2361 by 1568 pixels. Fundus photo. Macula at the center of the field
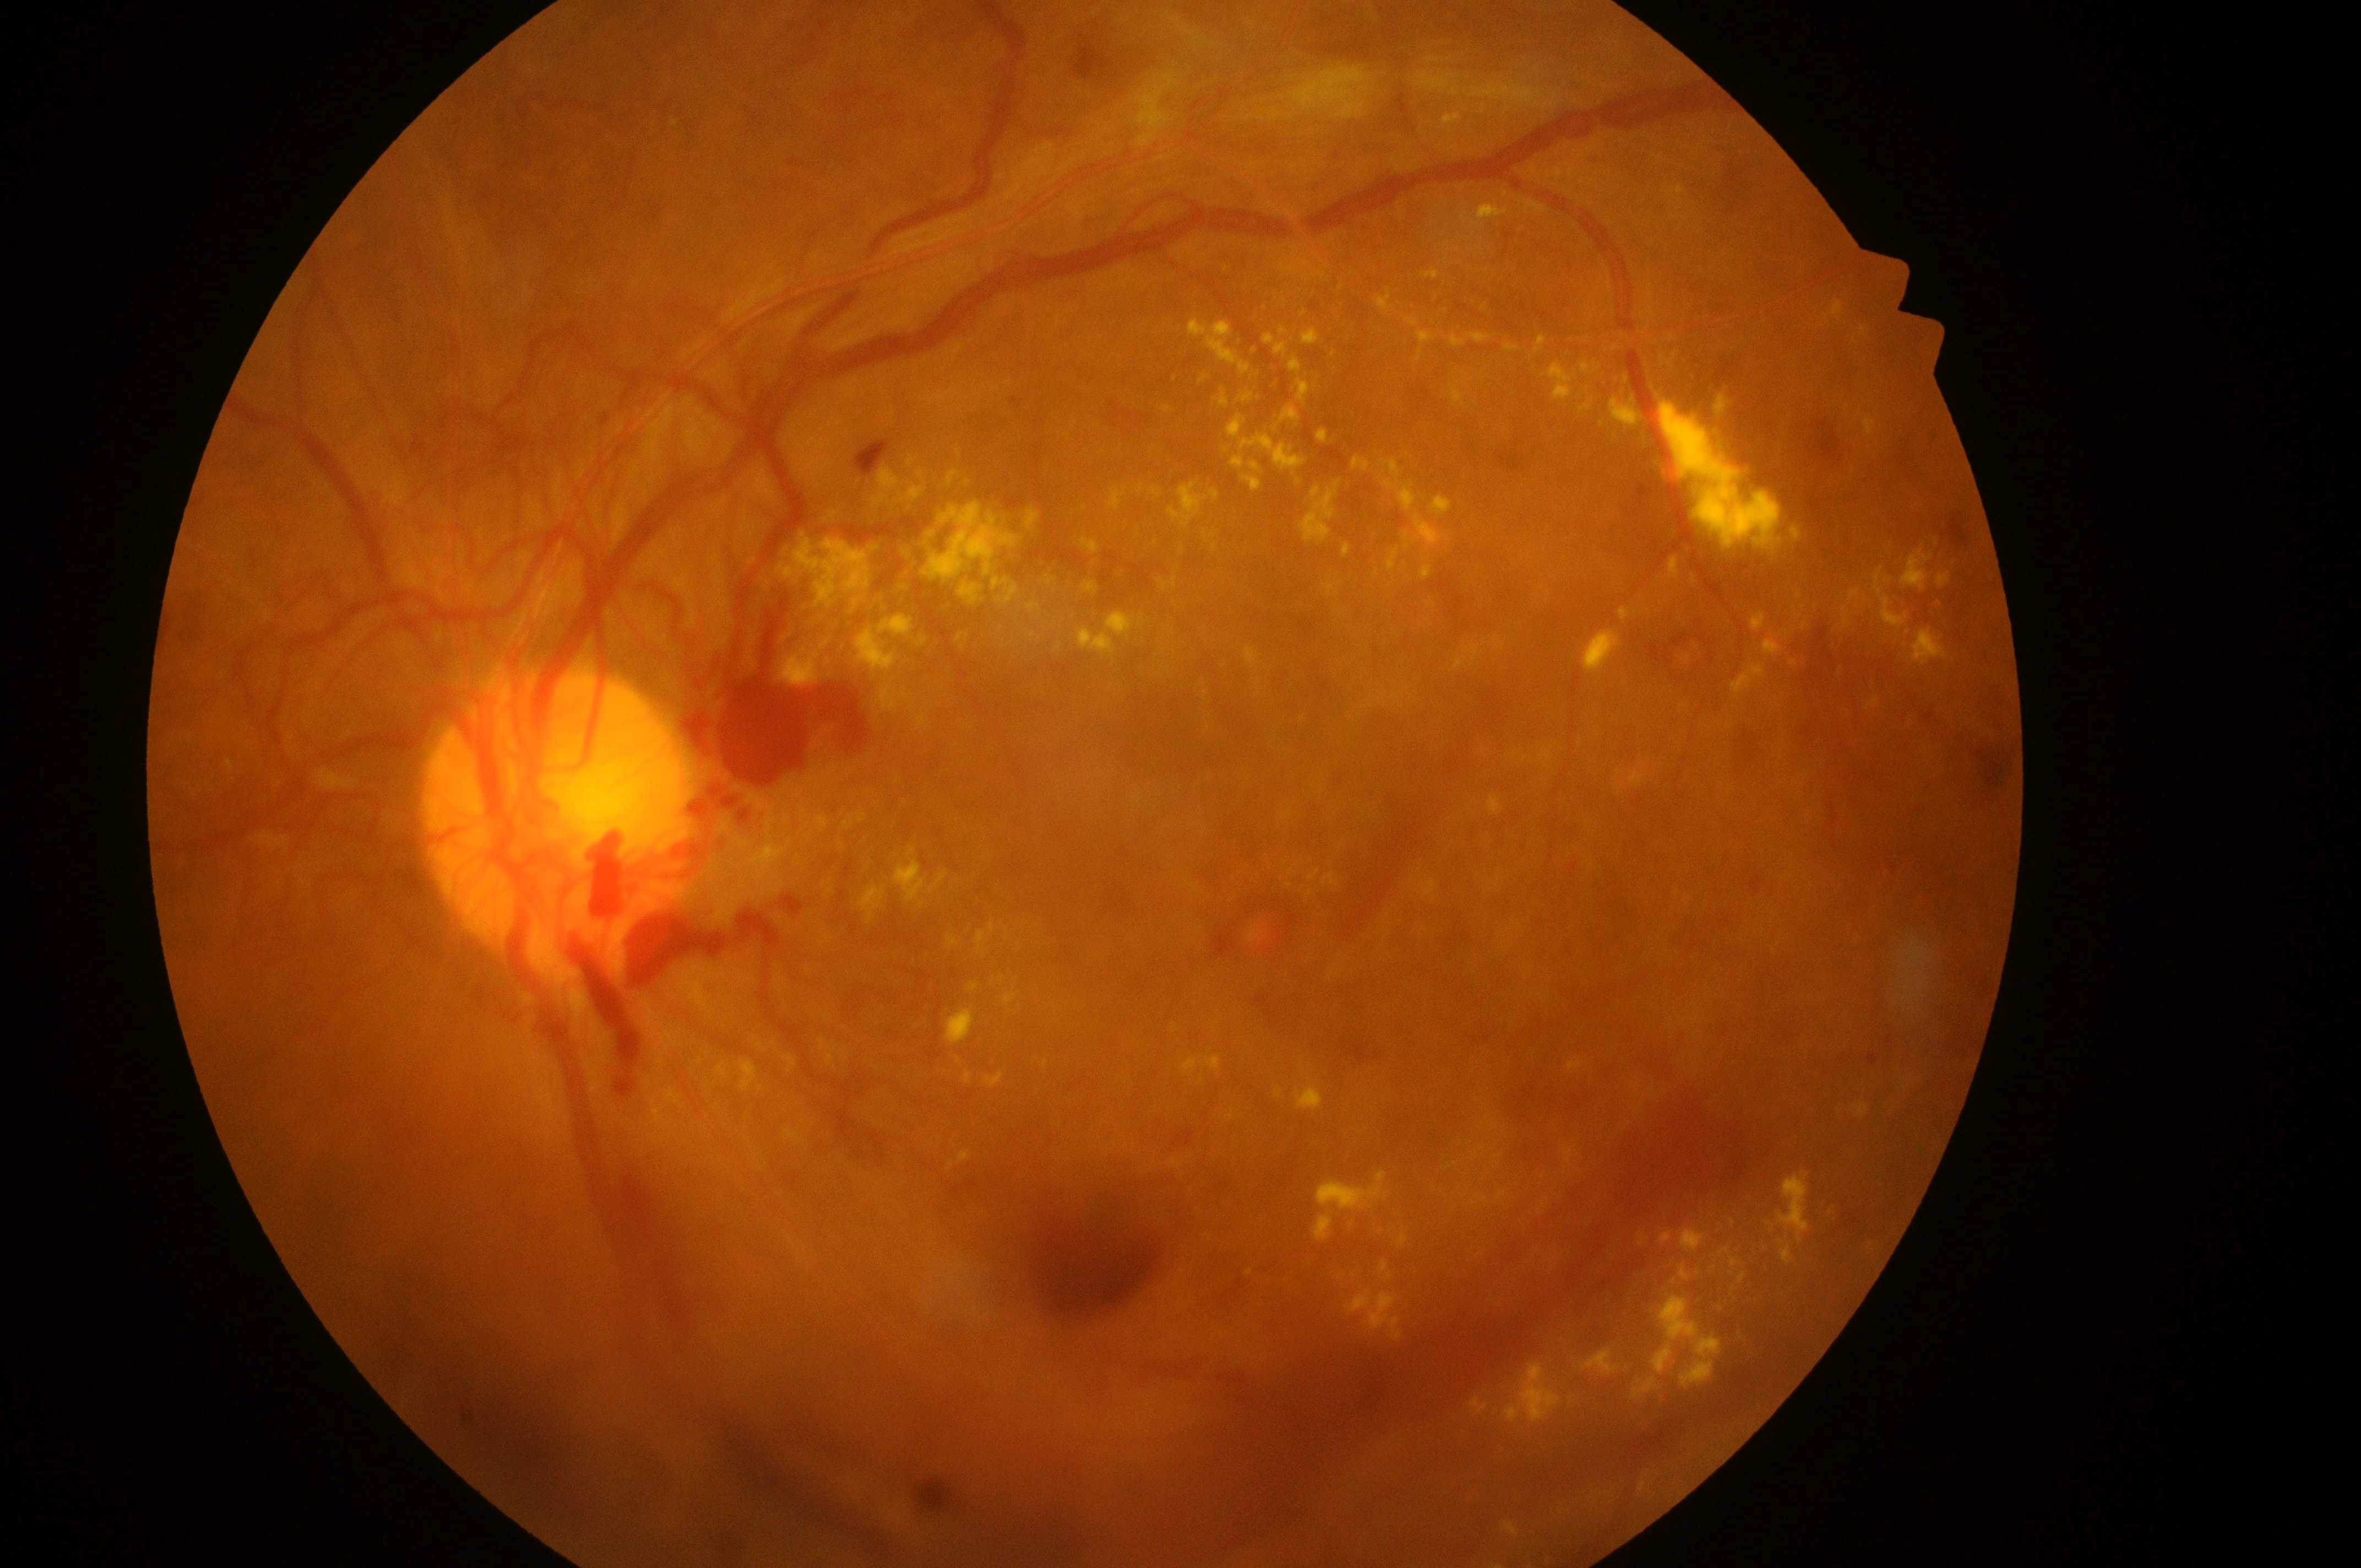
Annotations:
- fovea · (1287,923)
- optic nerve head · (554,829)
- diabetic retinopathy severity · grade 4 (PDR)
- laterality · left eye
- macular edema risk · grade 2 (high risk)